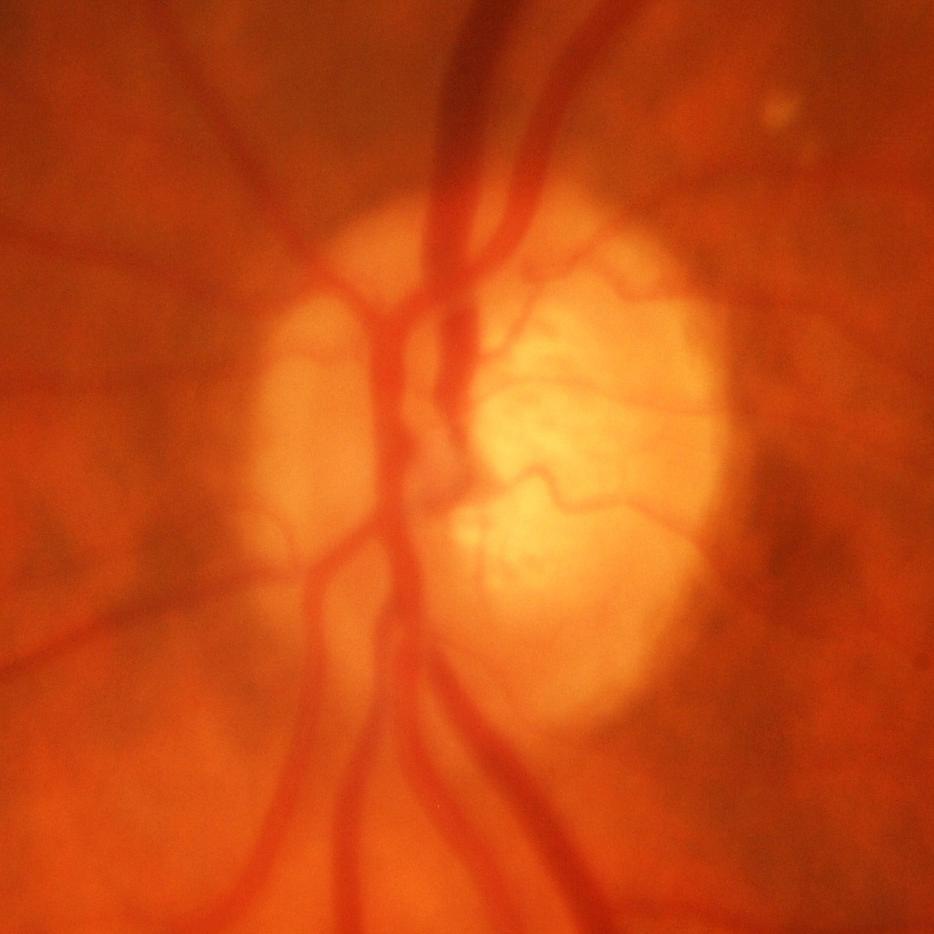
Glaucoma status = glaucomatous findings.